Image size 1440x1080 · wide-field contact fundus photograph of an infant.
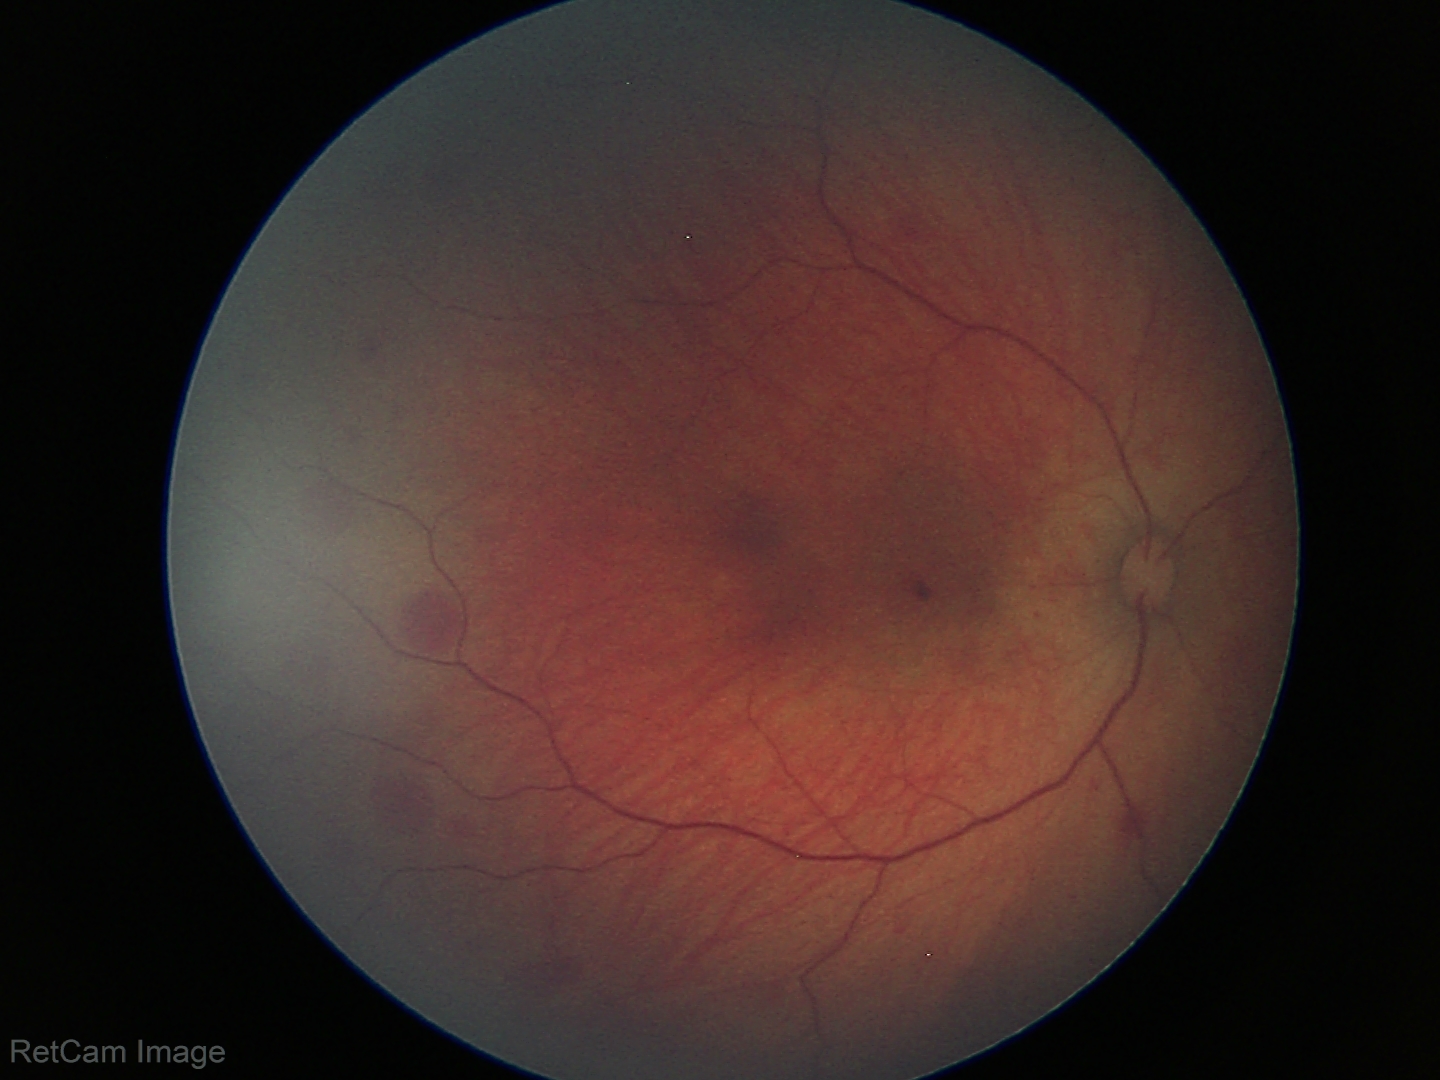

Diagnosis from this screening exam: retinal hemorrhages.